Optic disc-centered crop; non-mydriatic fundus camera; acquired with a Nidek AFC-330:
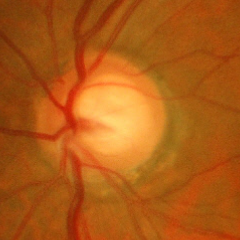

Q: Is glaucoma present?
A: Early glaucomatous changes.